Posterior pole view. 2228 x 1652 pixels:
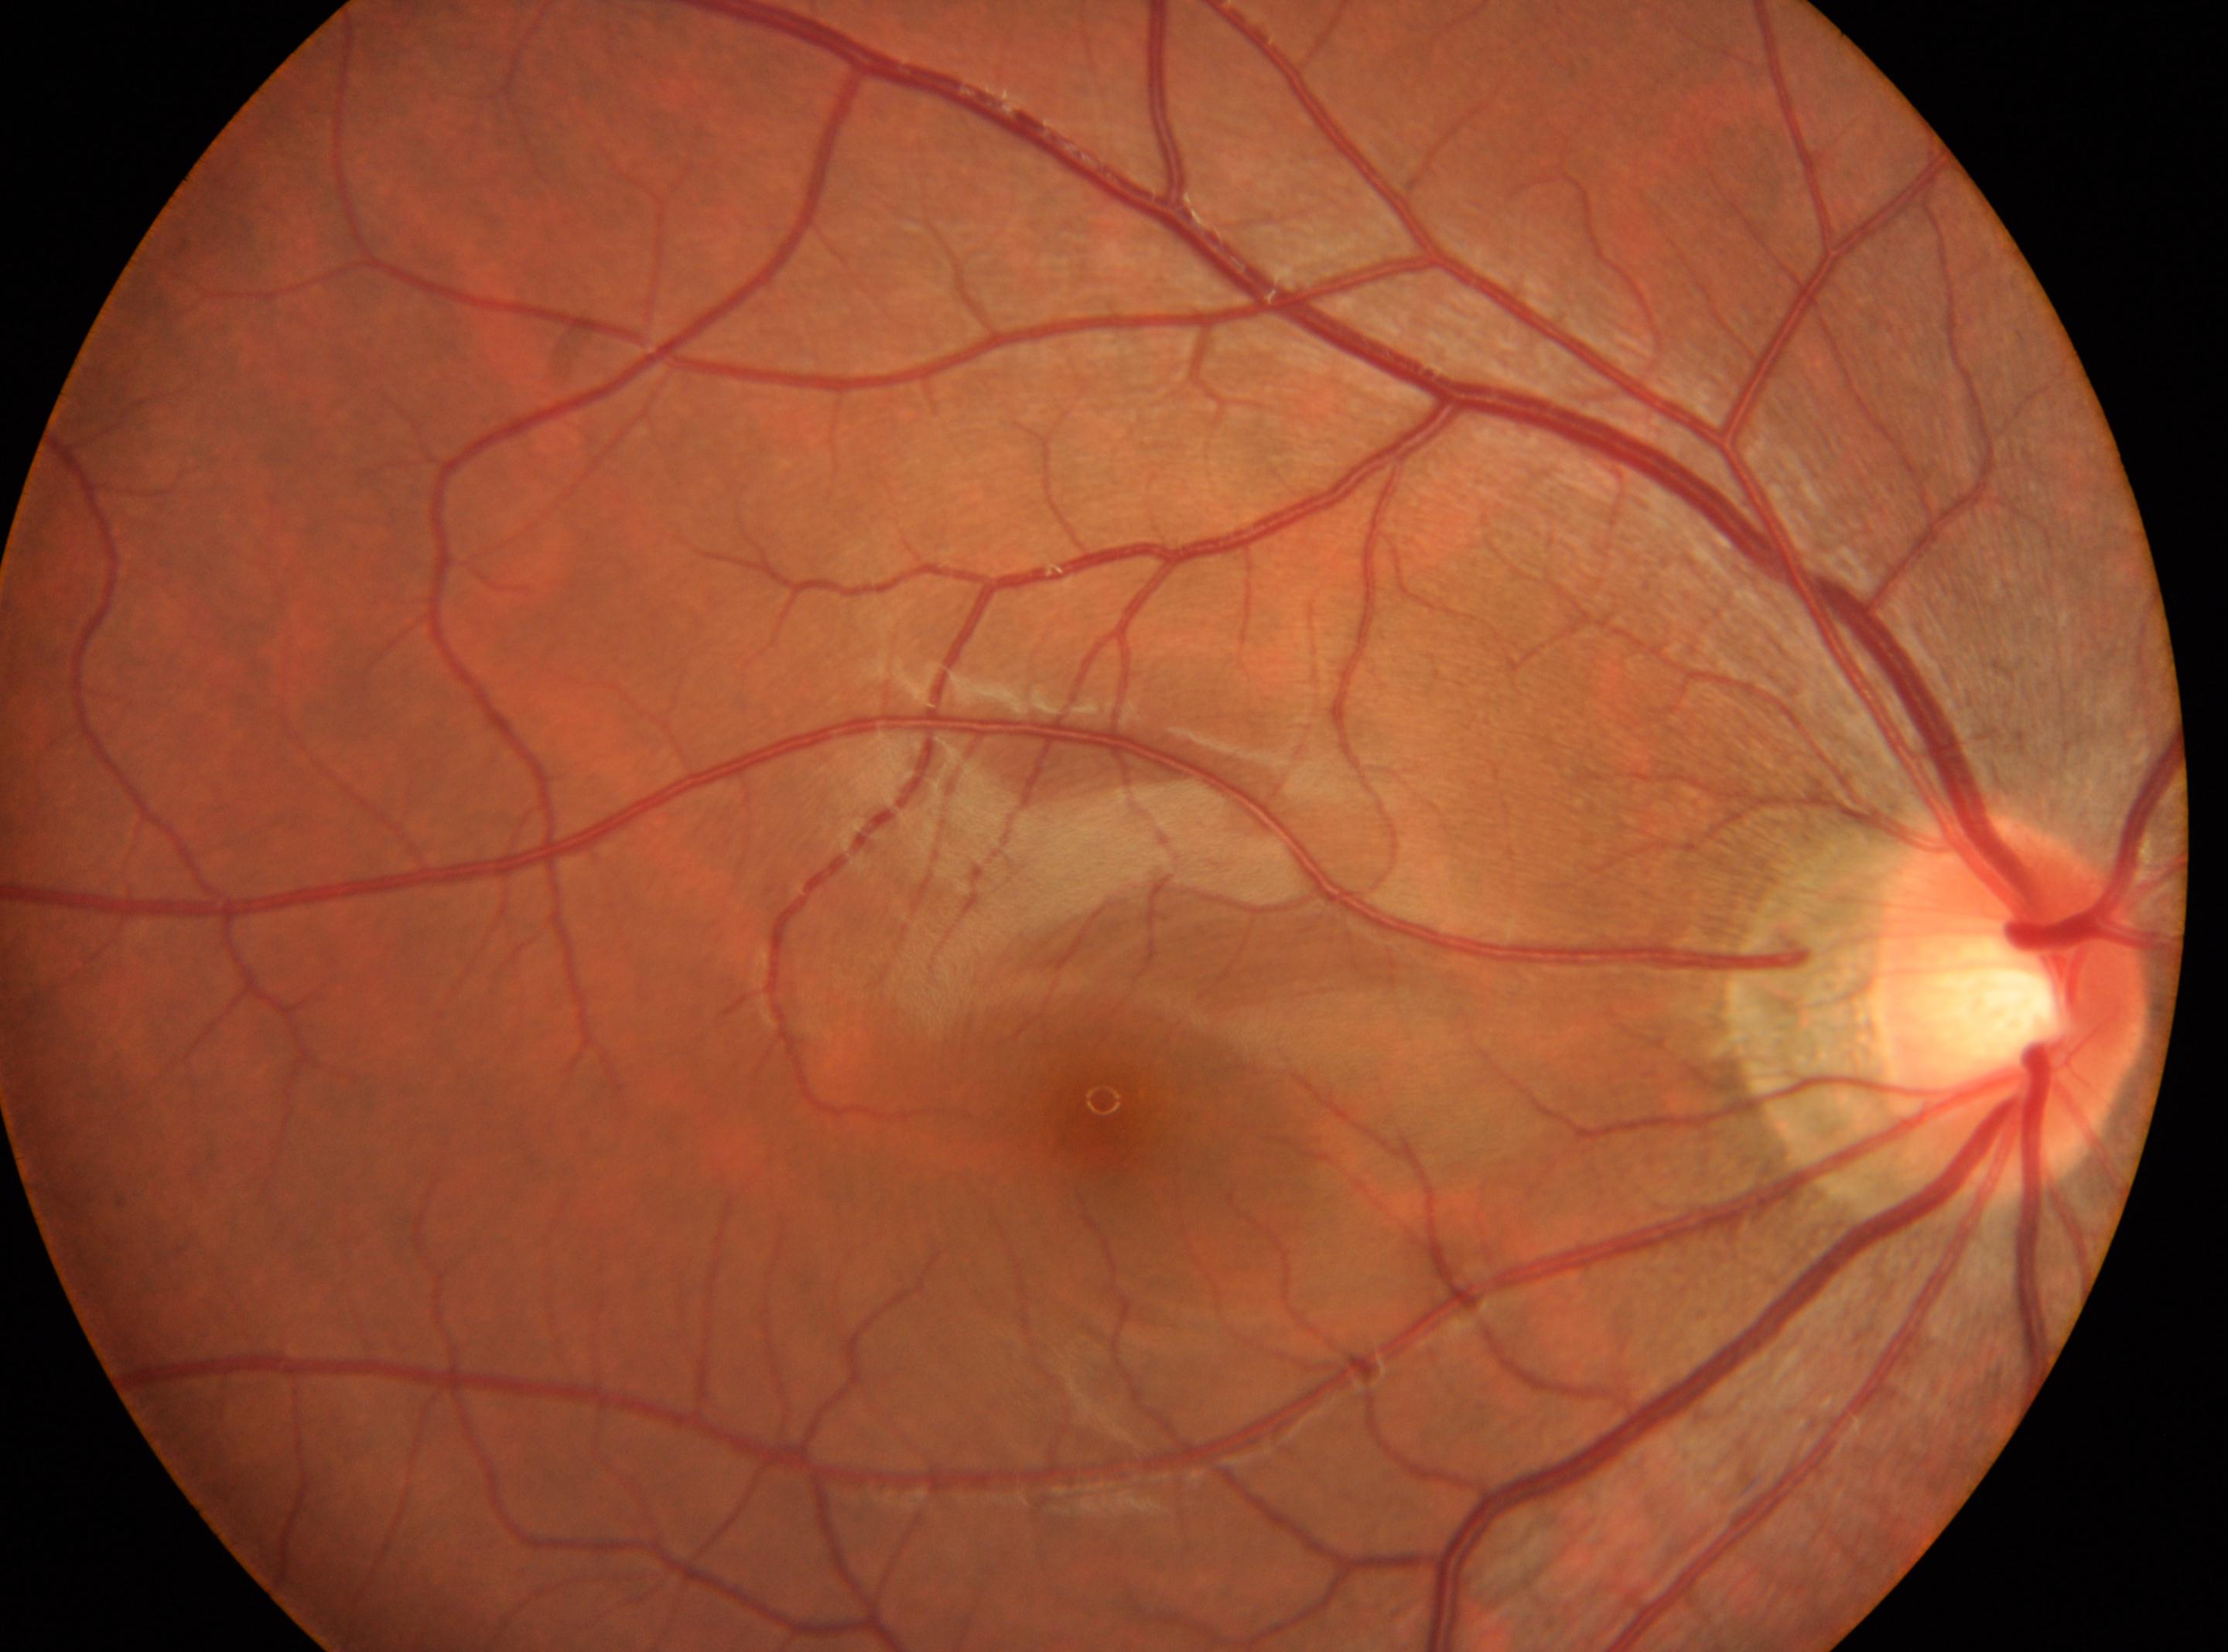 right; fovea center@(1103, 1112); optic disk@(2011, 1004); DR stage@0/4; No apparent diabetic retinopathy.